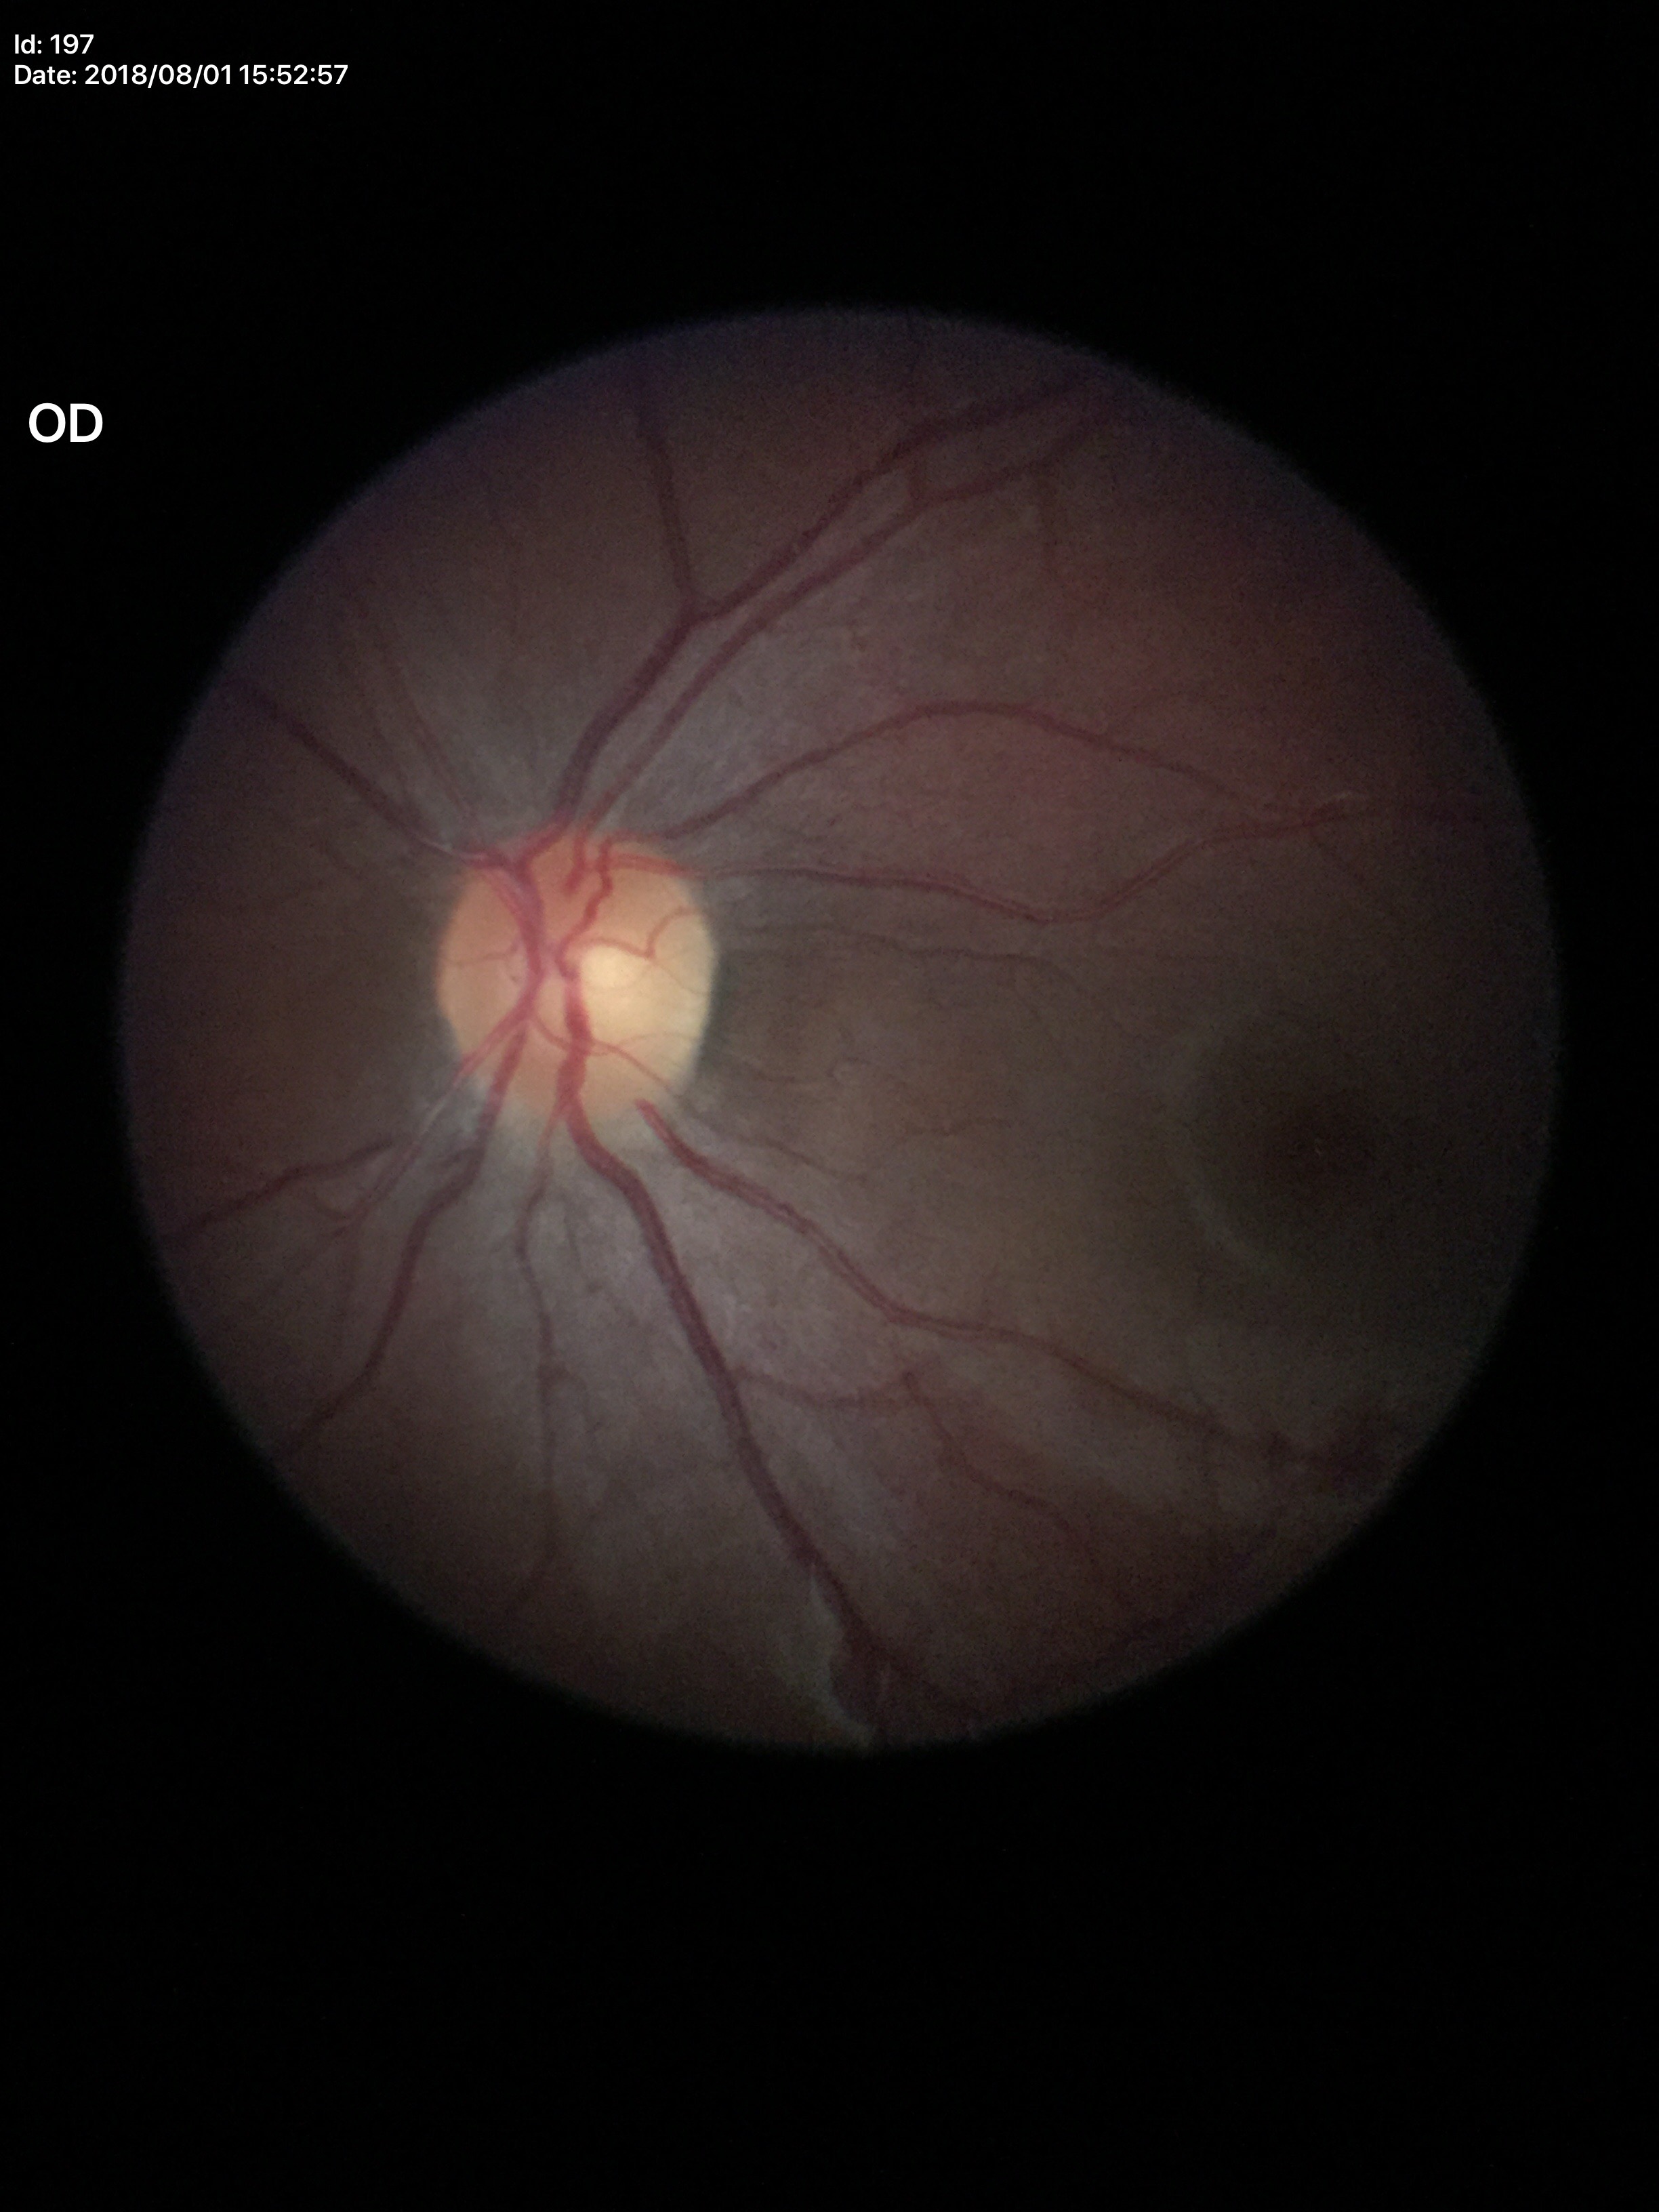

Optic disc analysis:
- Glaucoma impression — no suspicious findings
- vertical cup-disc ratio — 0.46